No pharmacologic dilation:
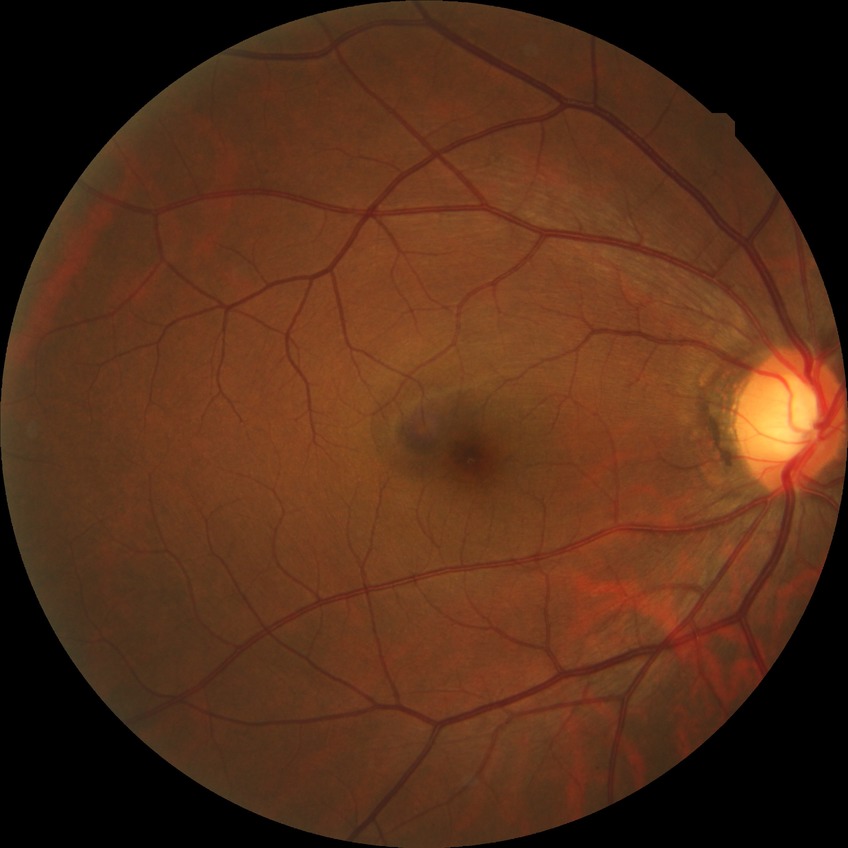
DR stage is NDR.
No diabetic retinal disease findings.